240 x 240 pixels. Acquired with a Nidek AFC-330 — 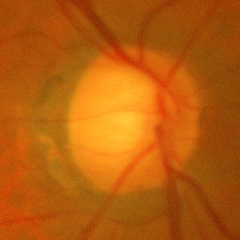

Early glaucomatous changes.